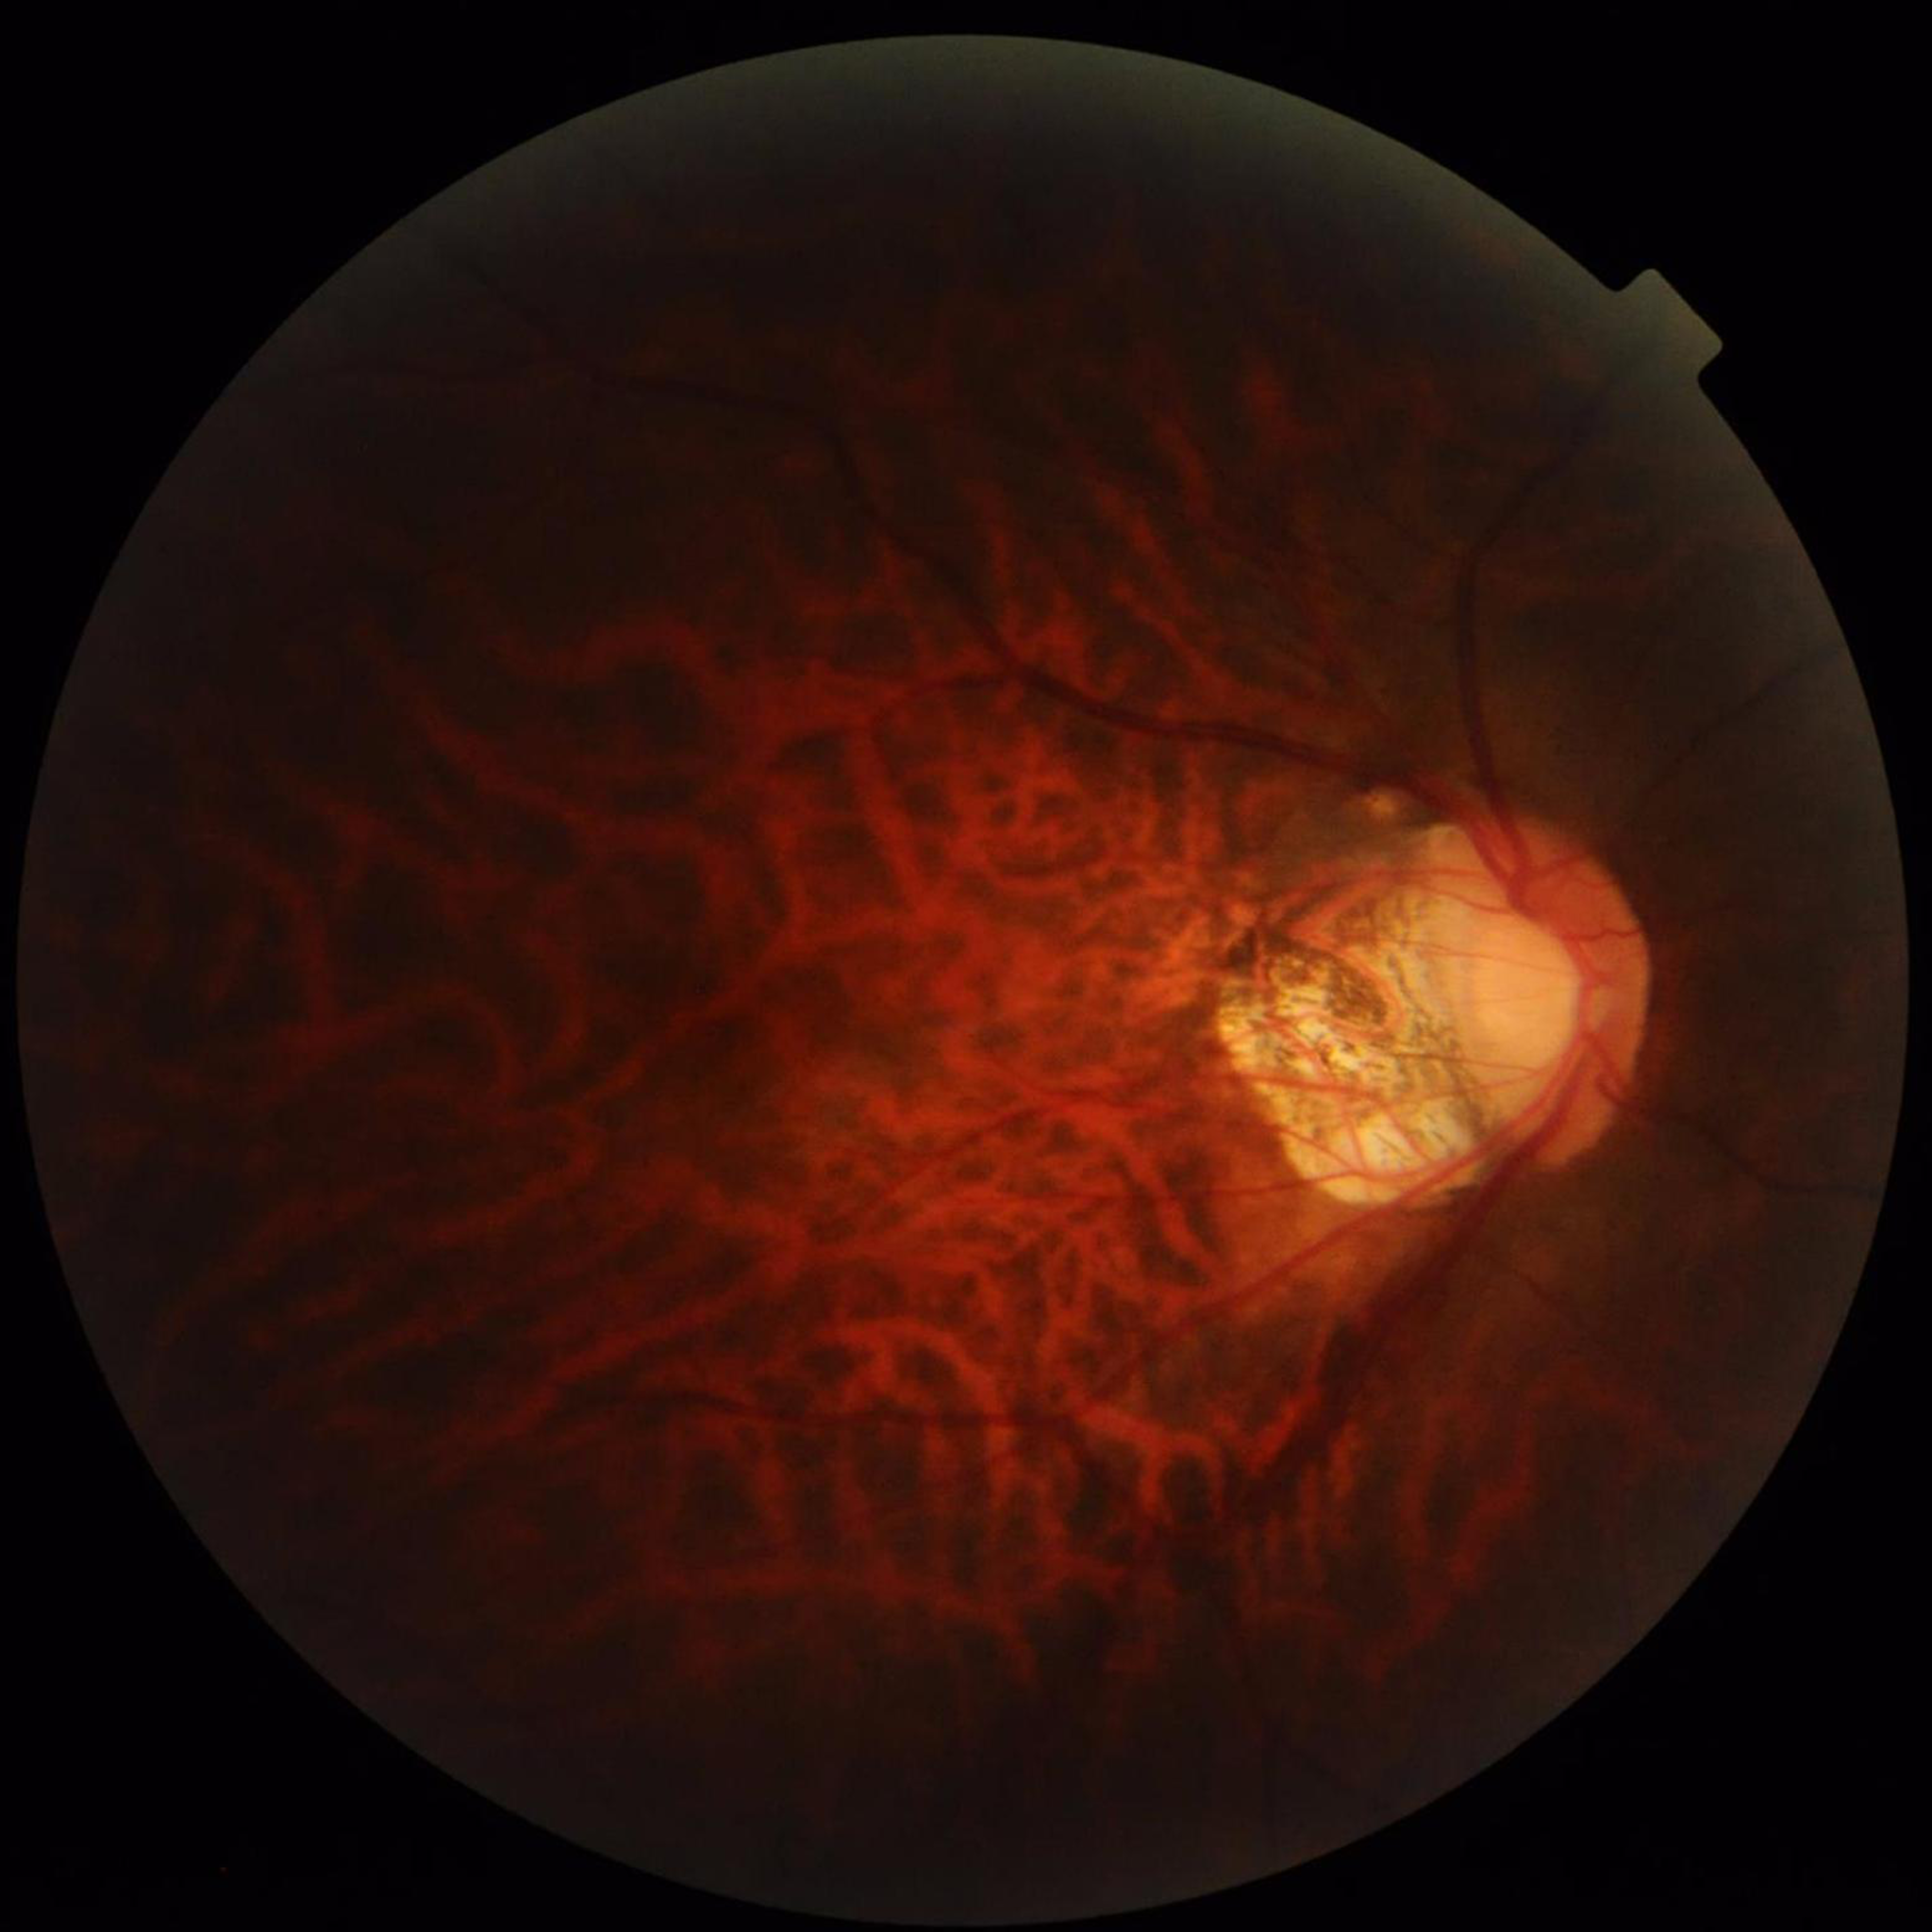
image_quality: issues noted — illumination/color distortion, low contrast, blur
diagnosis: glaucoma